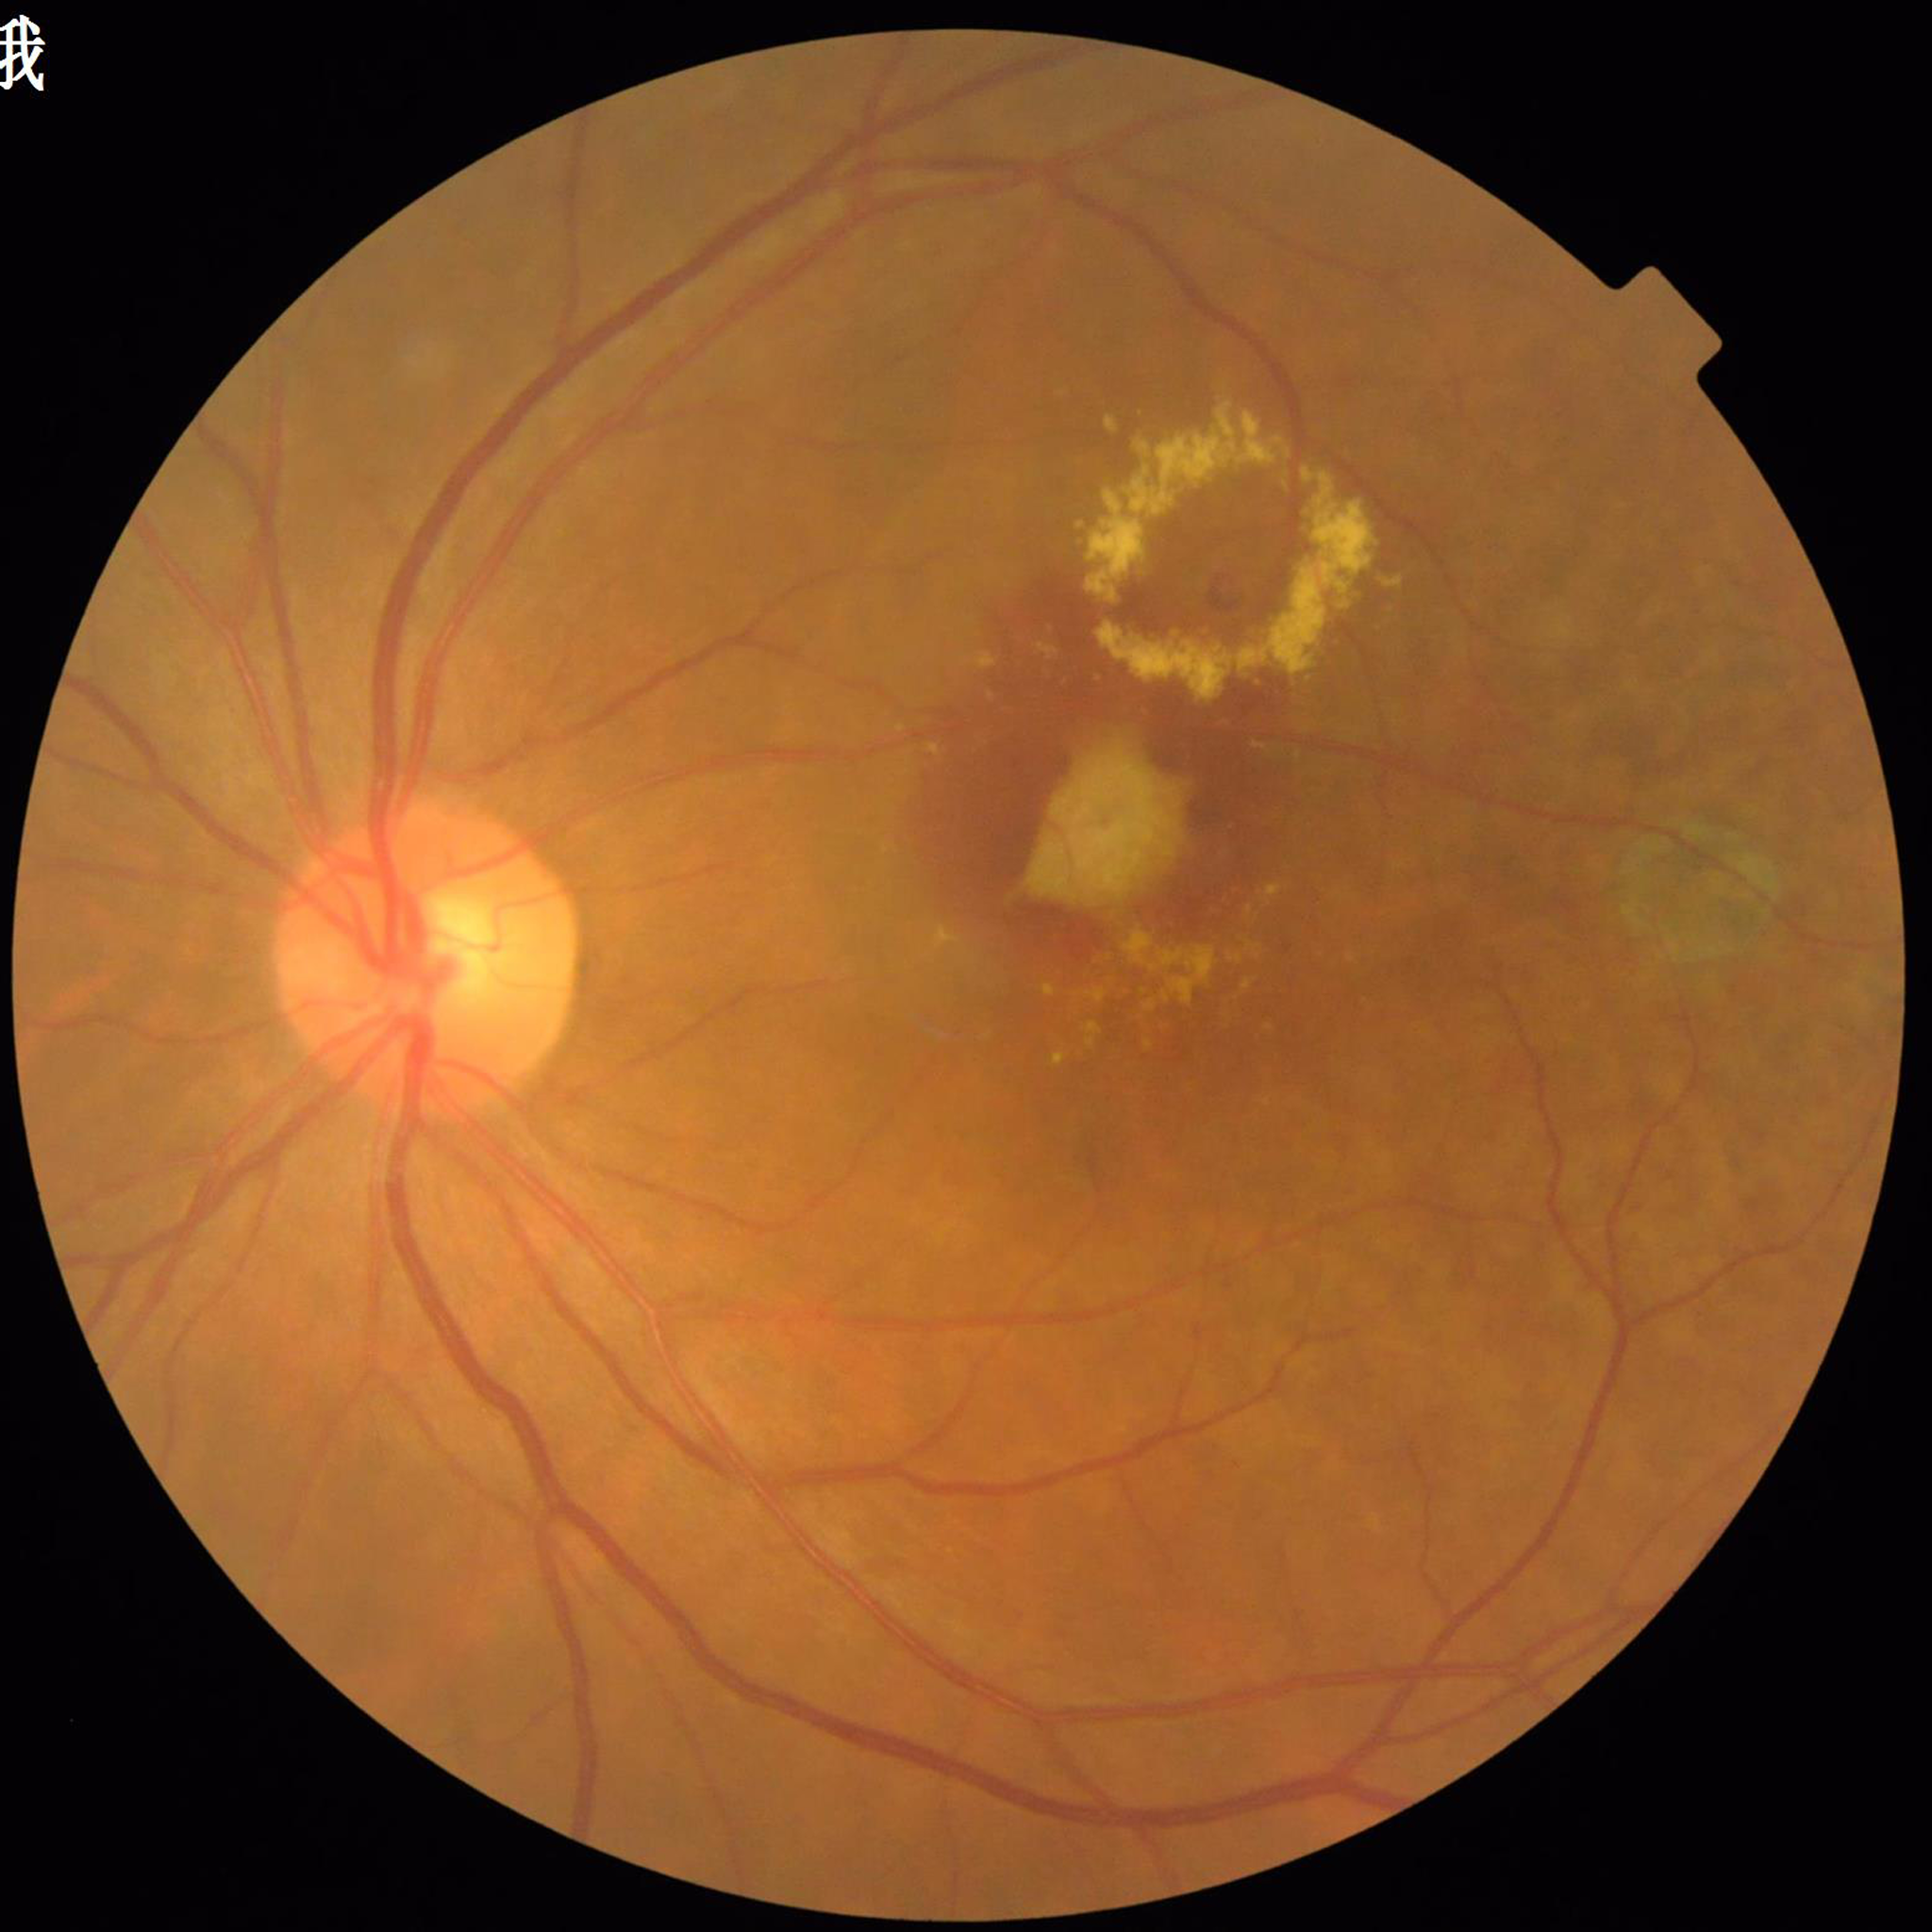

Image quality: satisfactory.
The patient was diagnosed with AMD.